45° FOV; color fundus image; 2352x1568px.
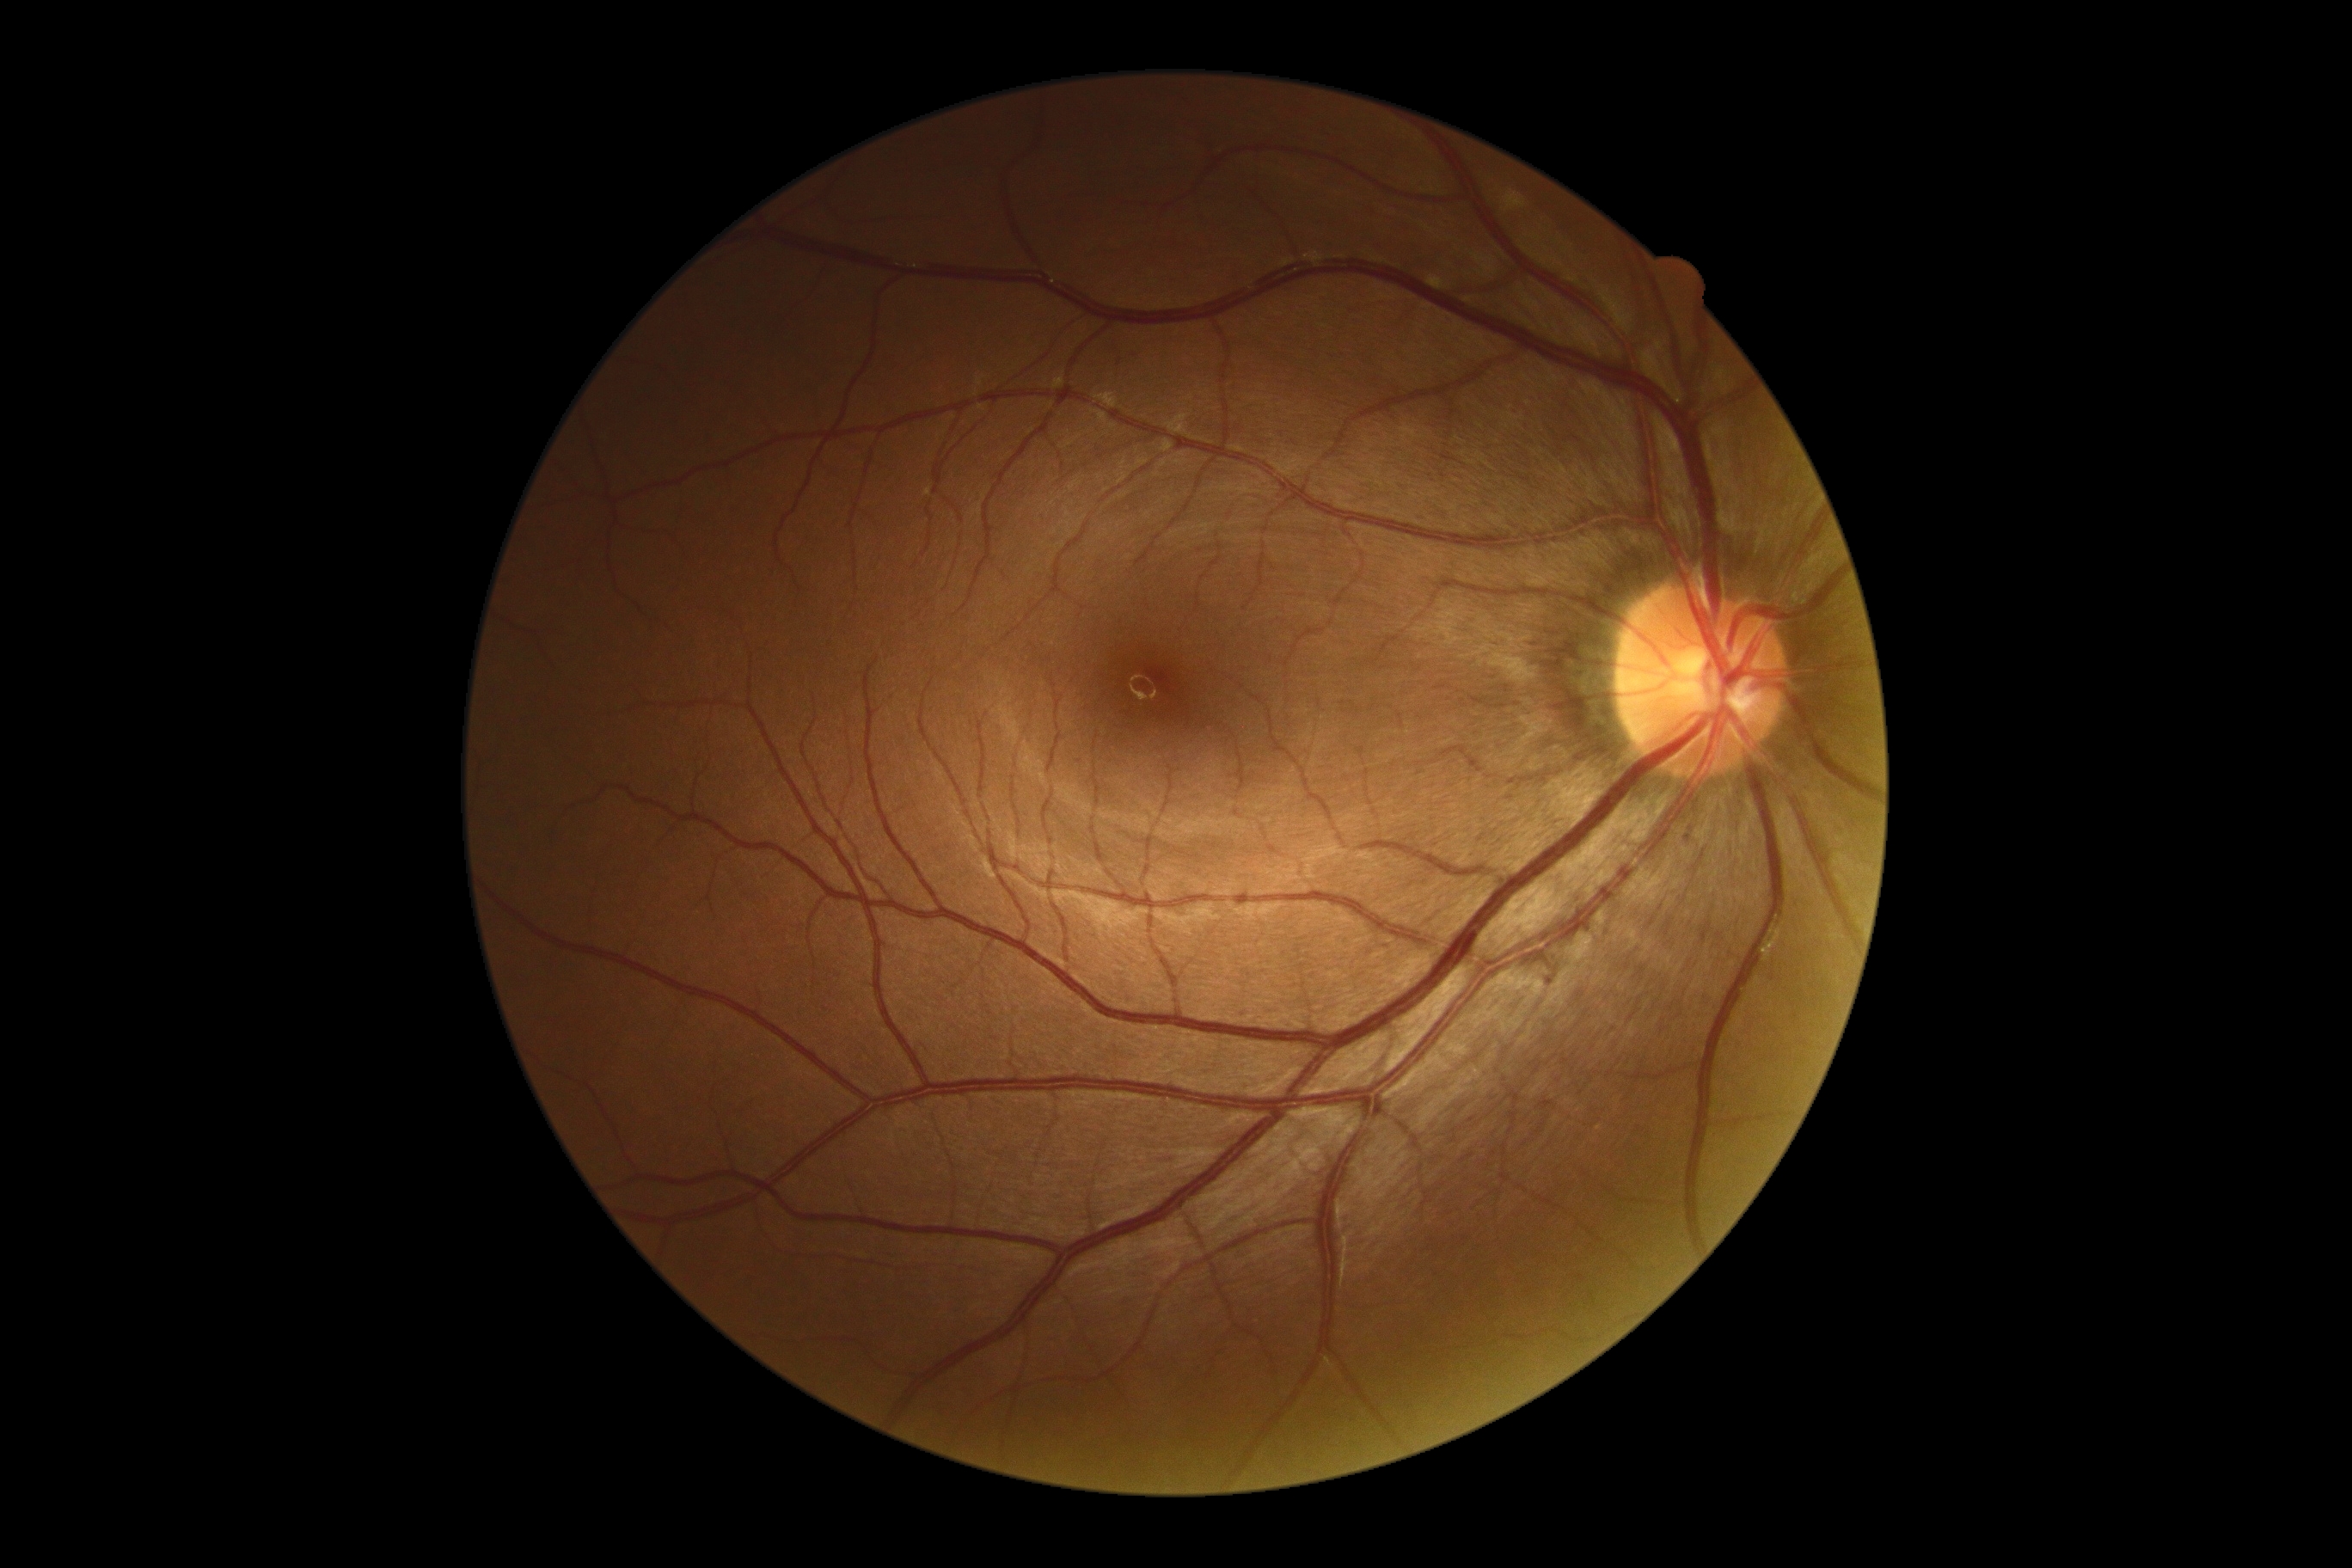 DR stage@0/4; DR impression@no apparent DR.